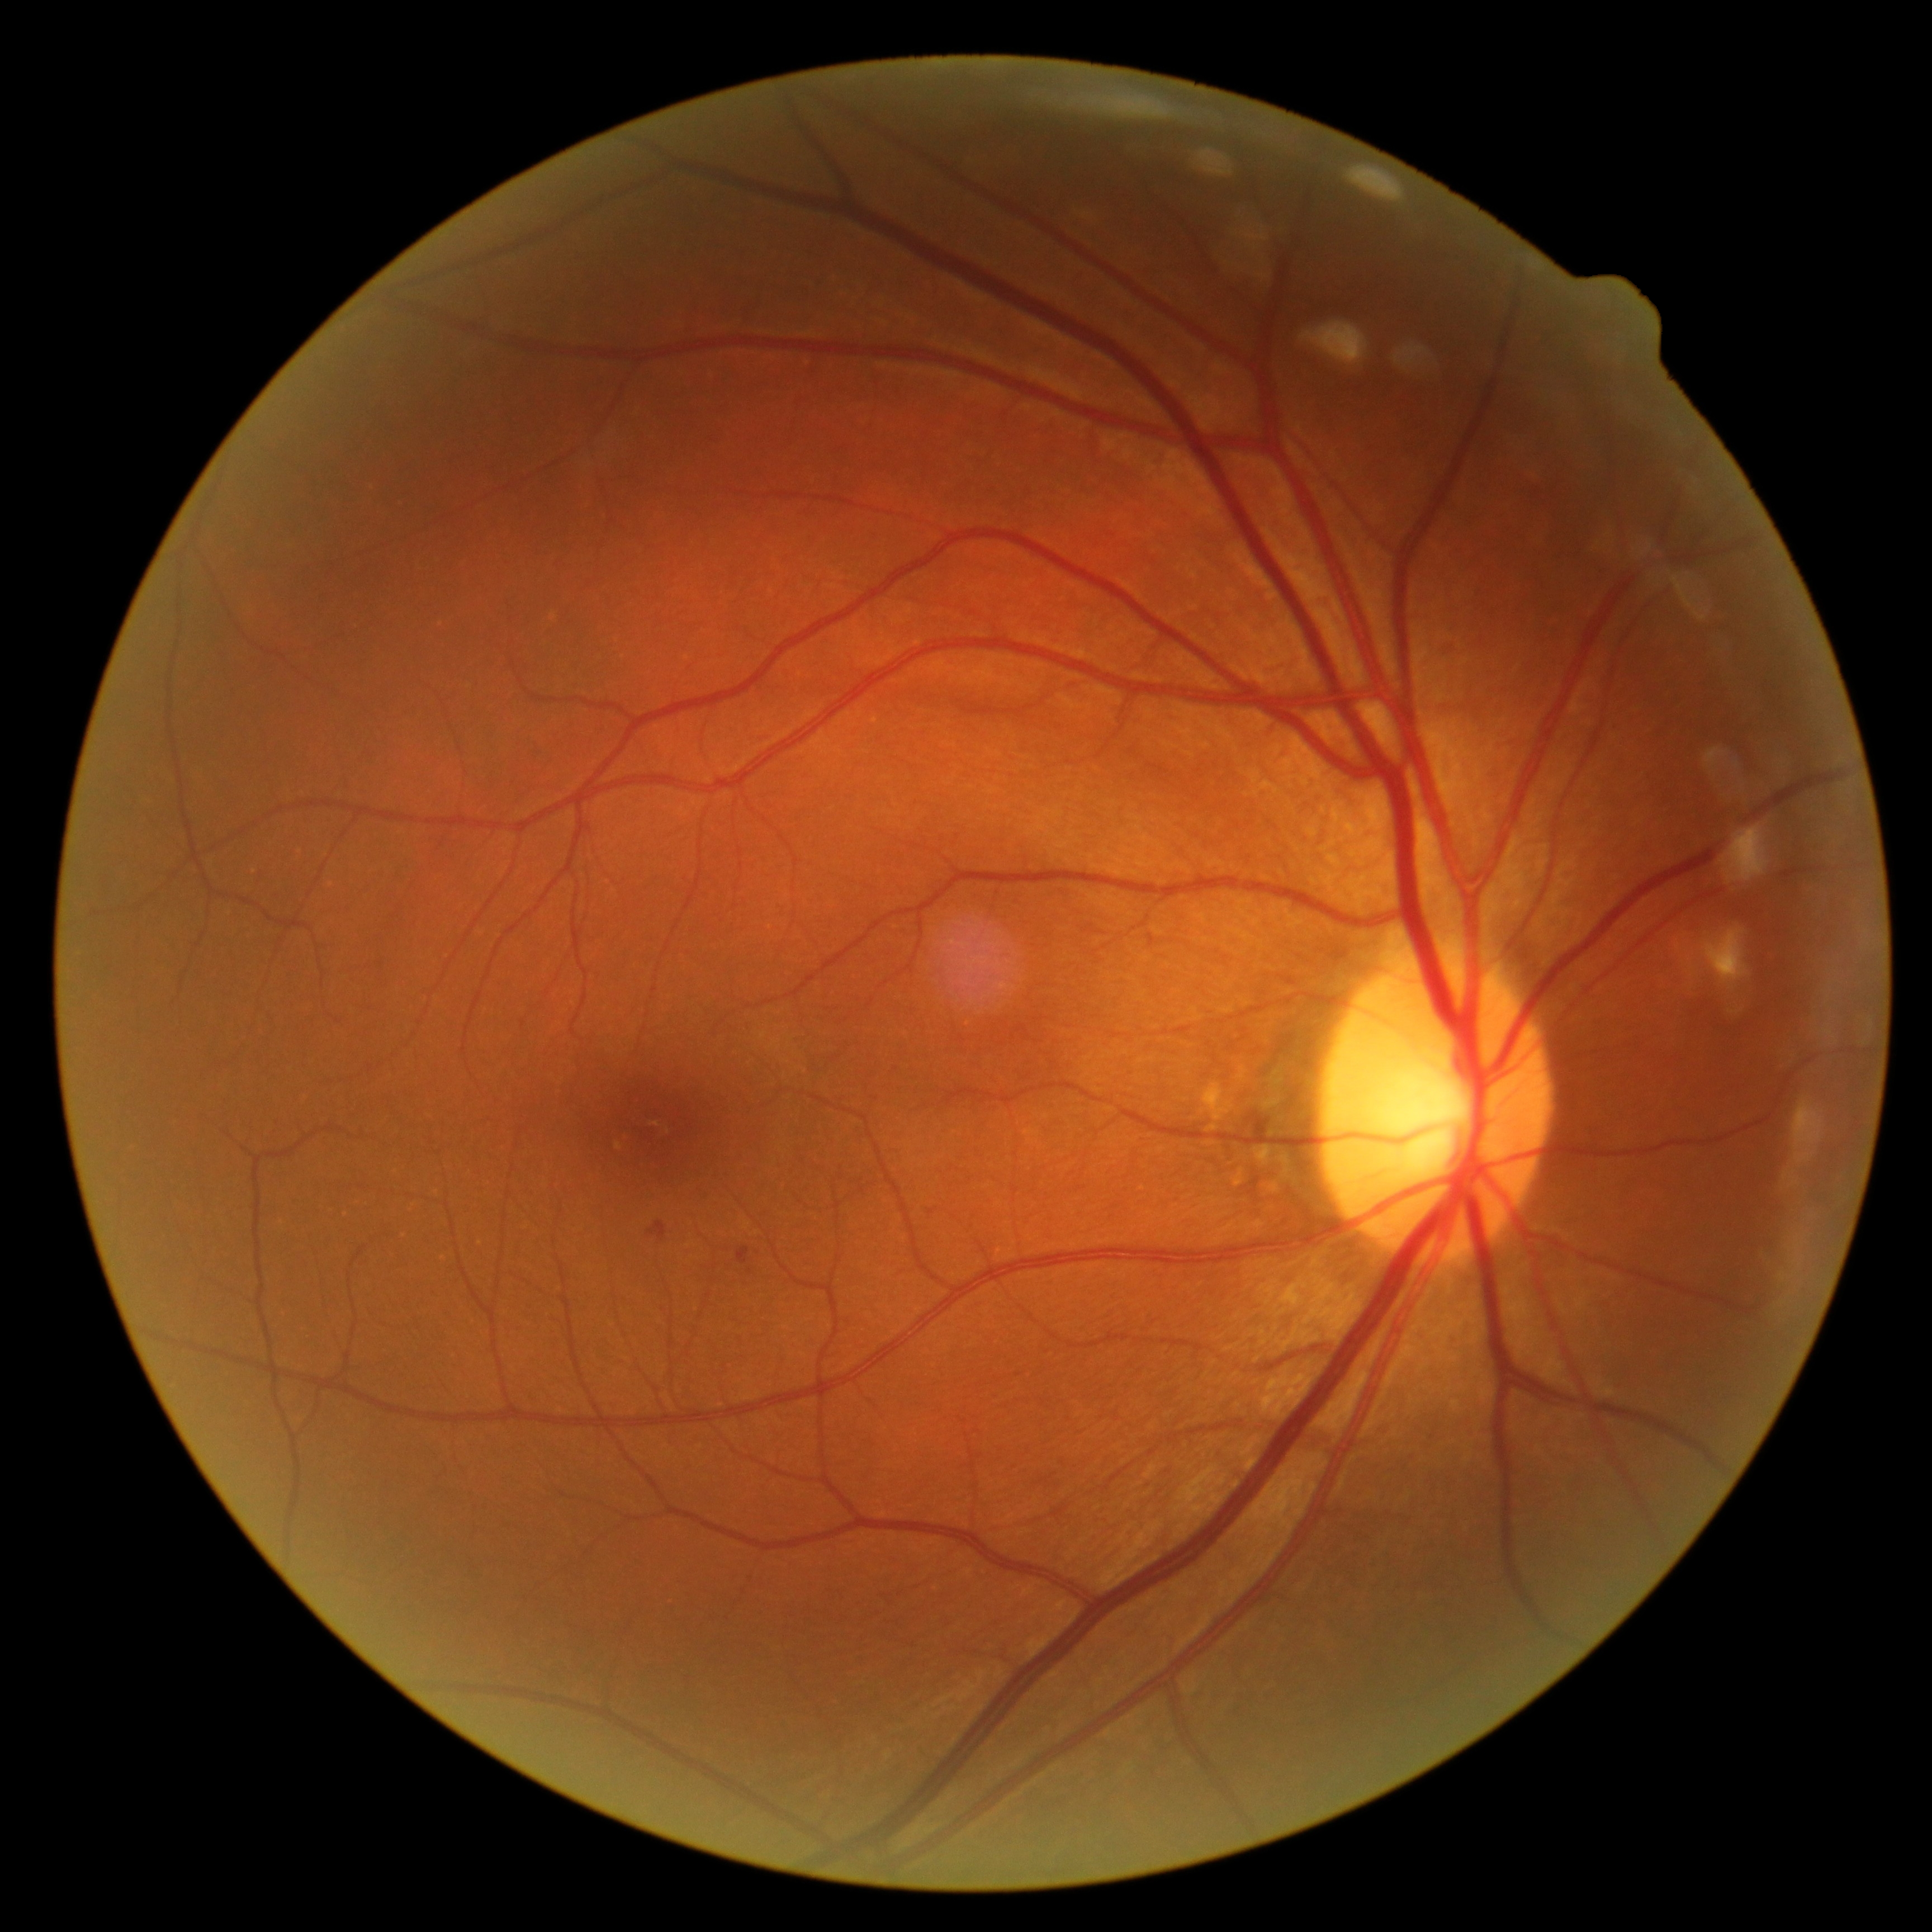
Diabetic retinopathy (DR): 2.